Optic nerve head crop · captured without pupil dilation
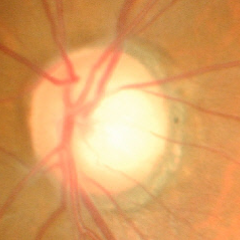

Glaucoma is present. Color fundus photograph showing advanced-stage glaucoma.